Nonmydriatic · Davis DR grading
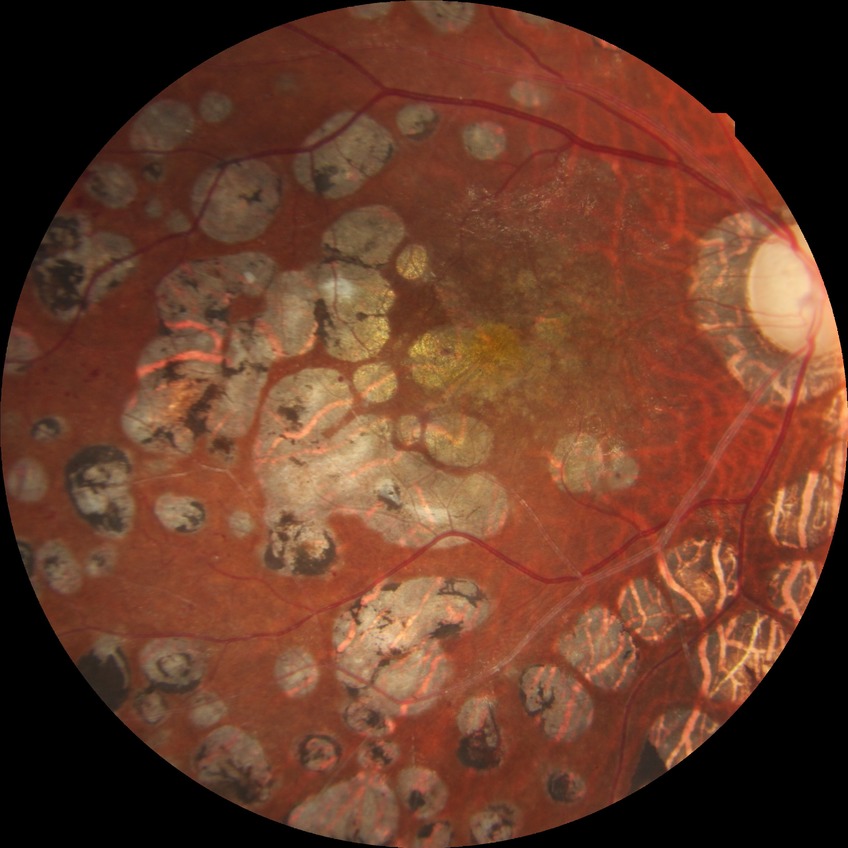
Findings:
– diabetic retinopathy (DR) — proliferative diabetic retinopathy (PDR)